Pediatric retinal photograph (wide-field): 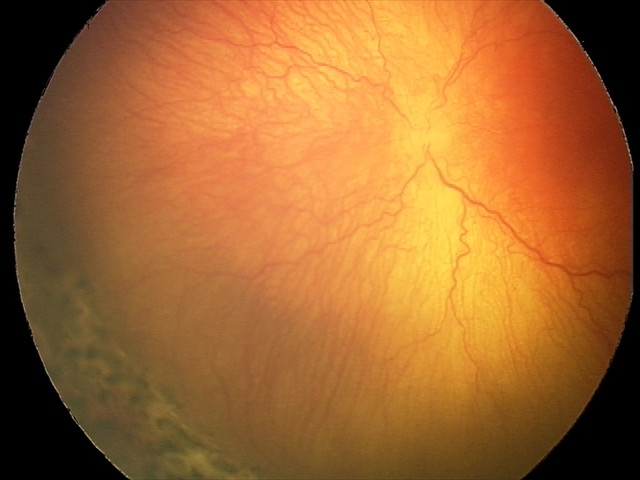
Screening examination consistent with A-ROP (aggressive ROP) — rapidly progressive severe ROP with prominent plus disease, often without classic stage progression.
Plus disease present.